848x848px · no pharmacologic dilation.
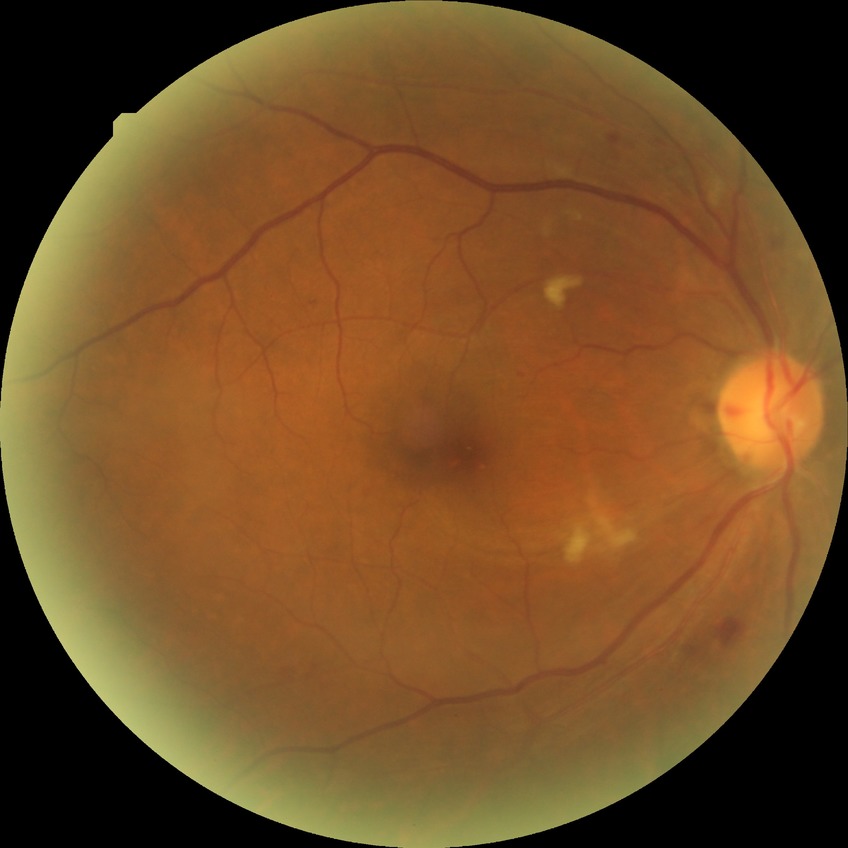

Findings:
– diabetic retinopathy (DR): pre-proliferative diabetic retinopathy (PPDR)